Davis DR grading:
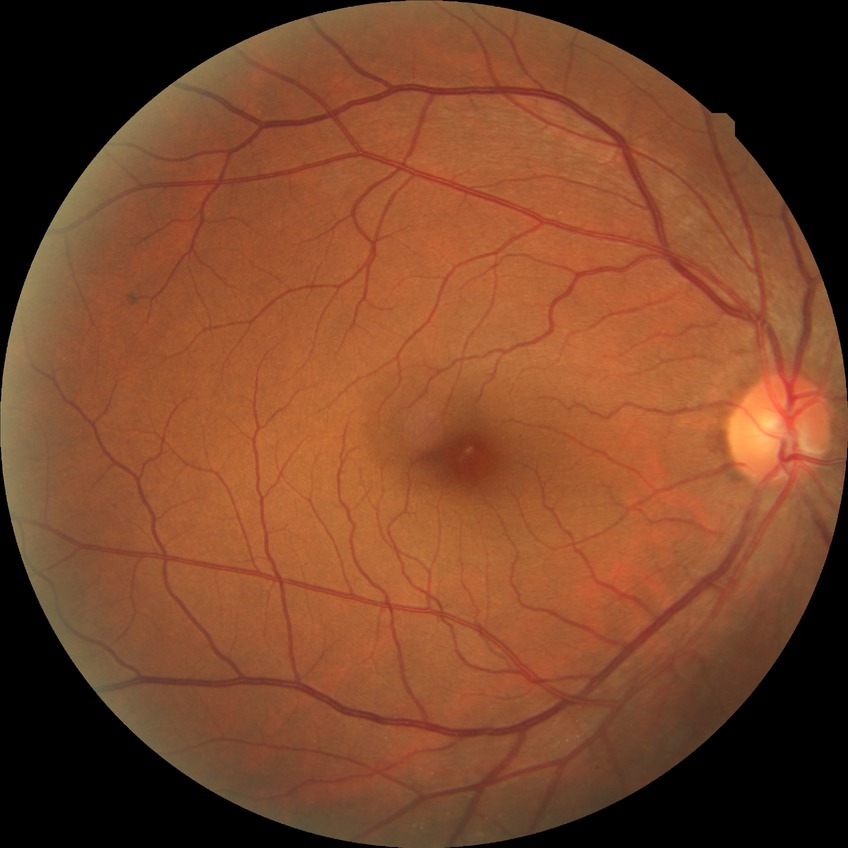

Diabetic retinopathy (DR) is no diabetic retinopathy (NDR).